Camera: Clarity RetCam 3 (130° FOV). Wide-field contact fundus photograph of an infant:
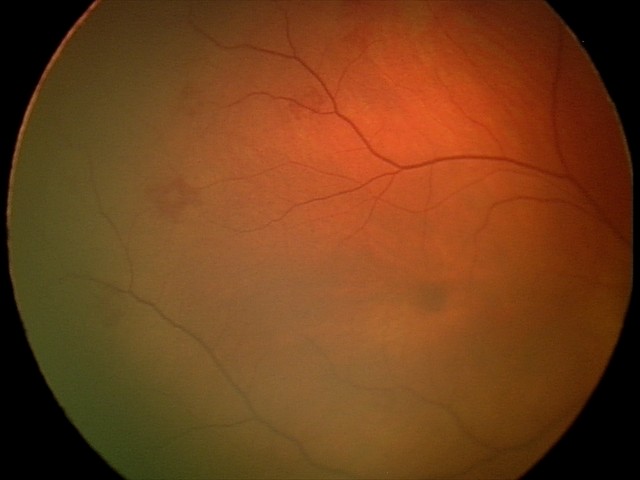 Screening: retinal hemorrhages.